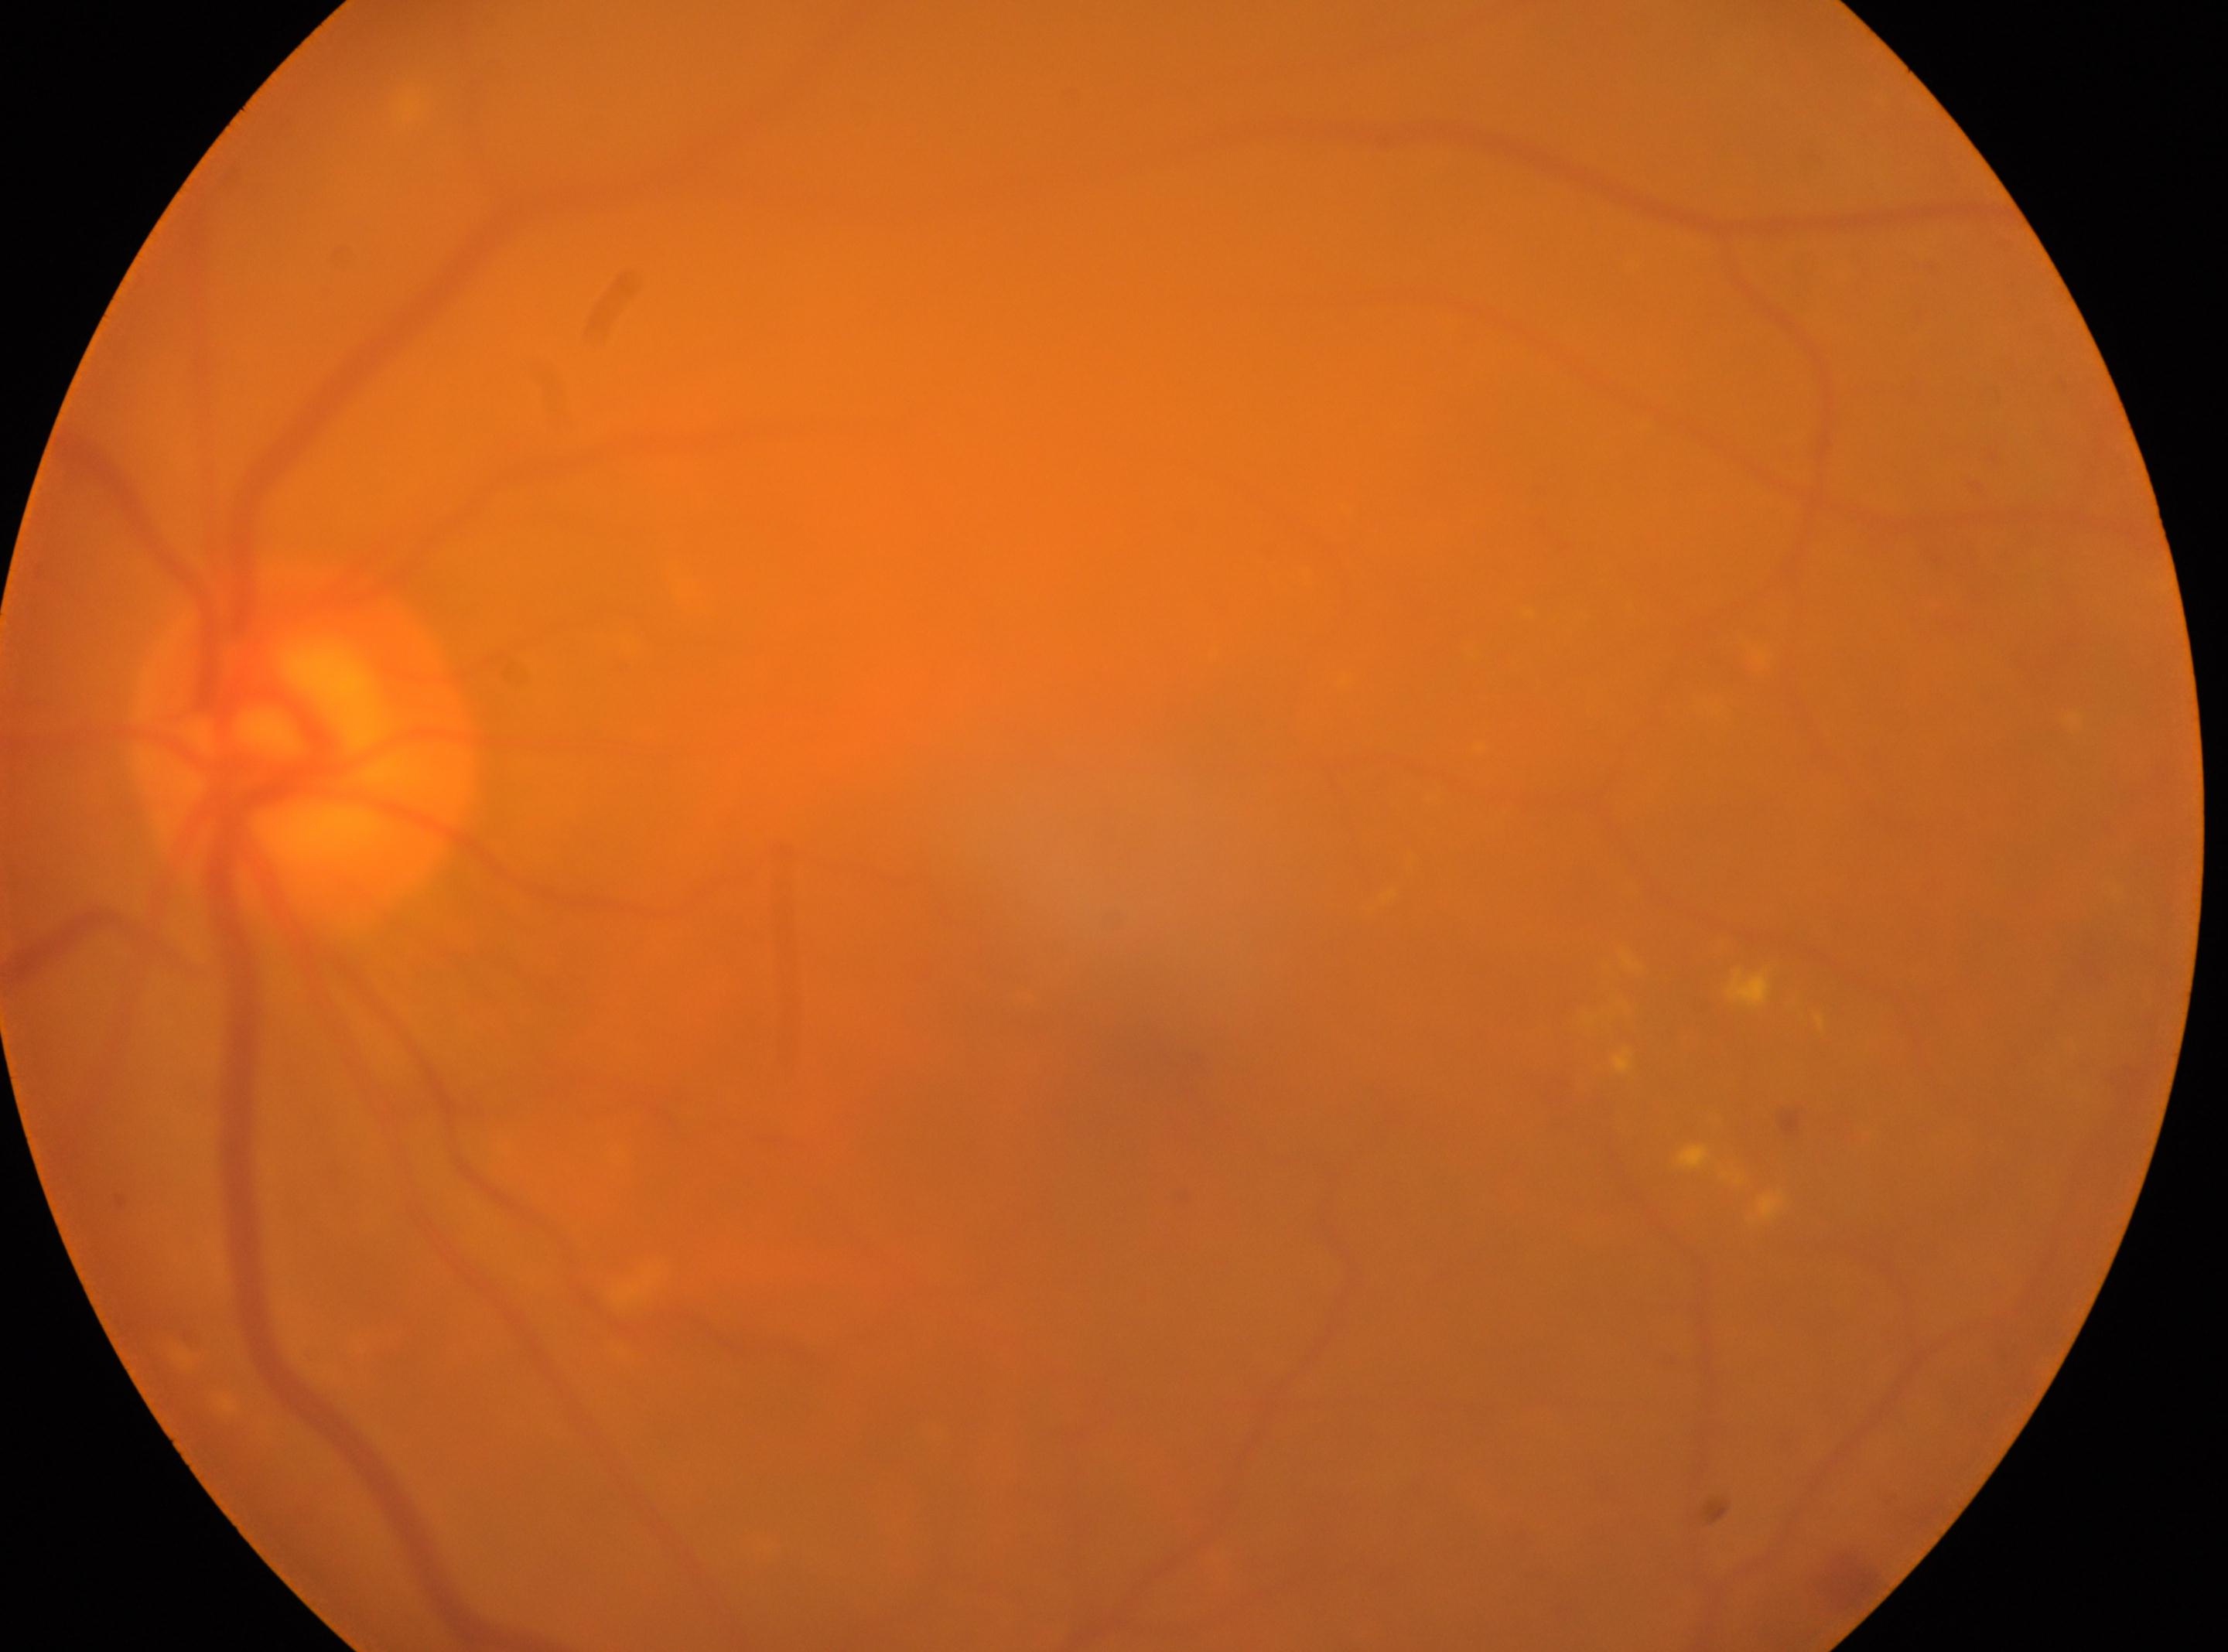 This is the left eye. Optic disc: (300, 752). Macula center located at (1164, 1041). Diabetic retinopathy: 2.